848 x 848 pixels, 45° field of view, color fundus photograph, without pupil dilation
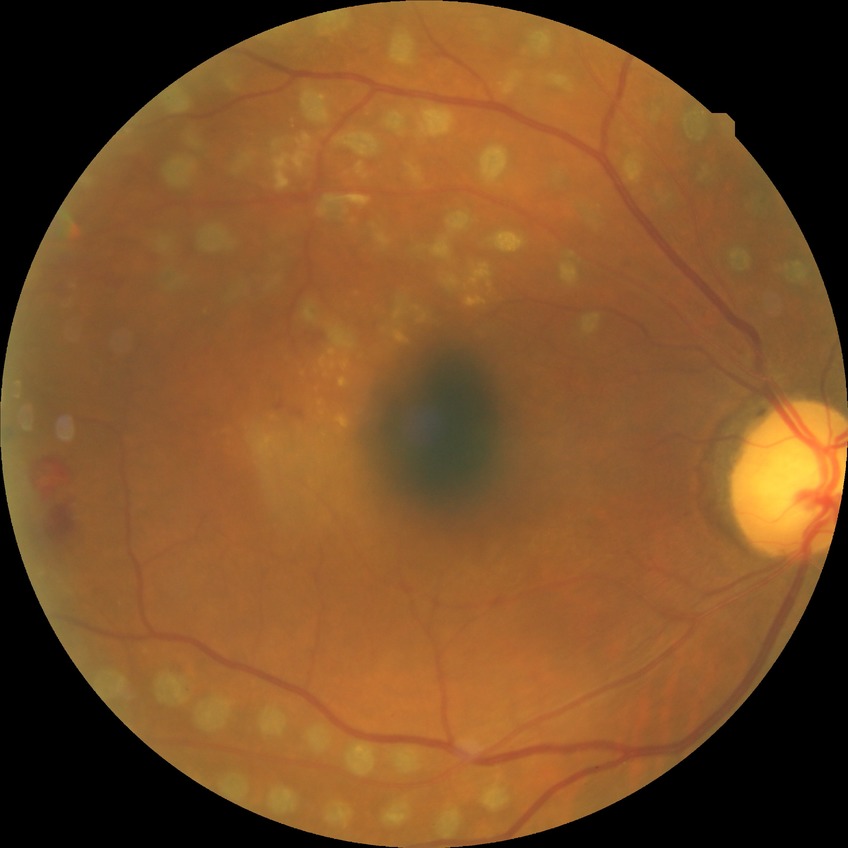
Diabetic retinopathy (DR) is PDR (proliferative diabetic retinopathy).